2212 x 1659 pixels. 60° field of view. Color fundus photograph from a handheld portable camera: 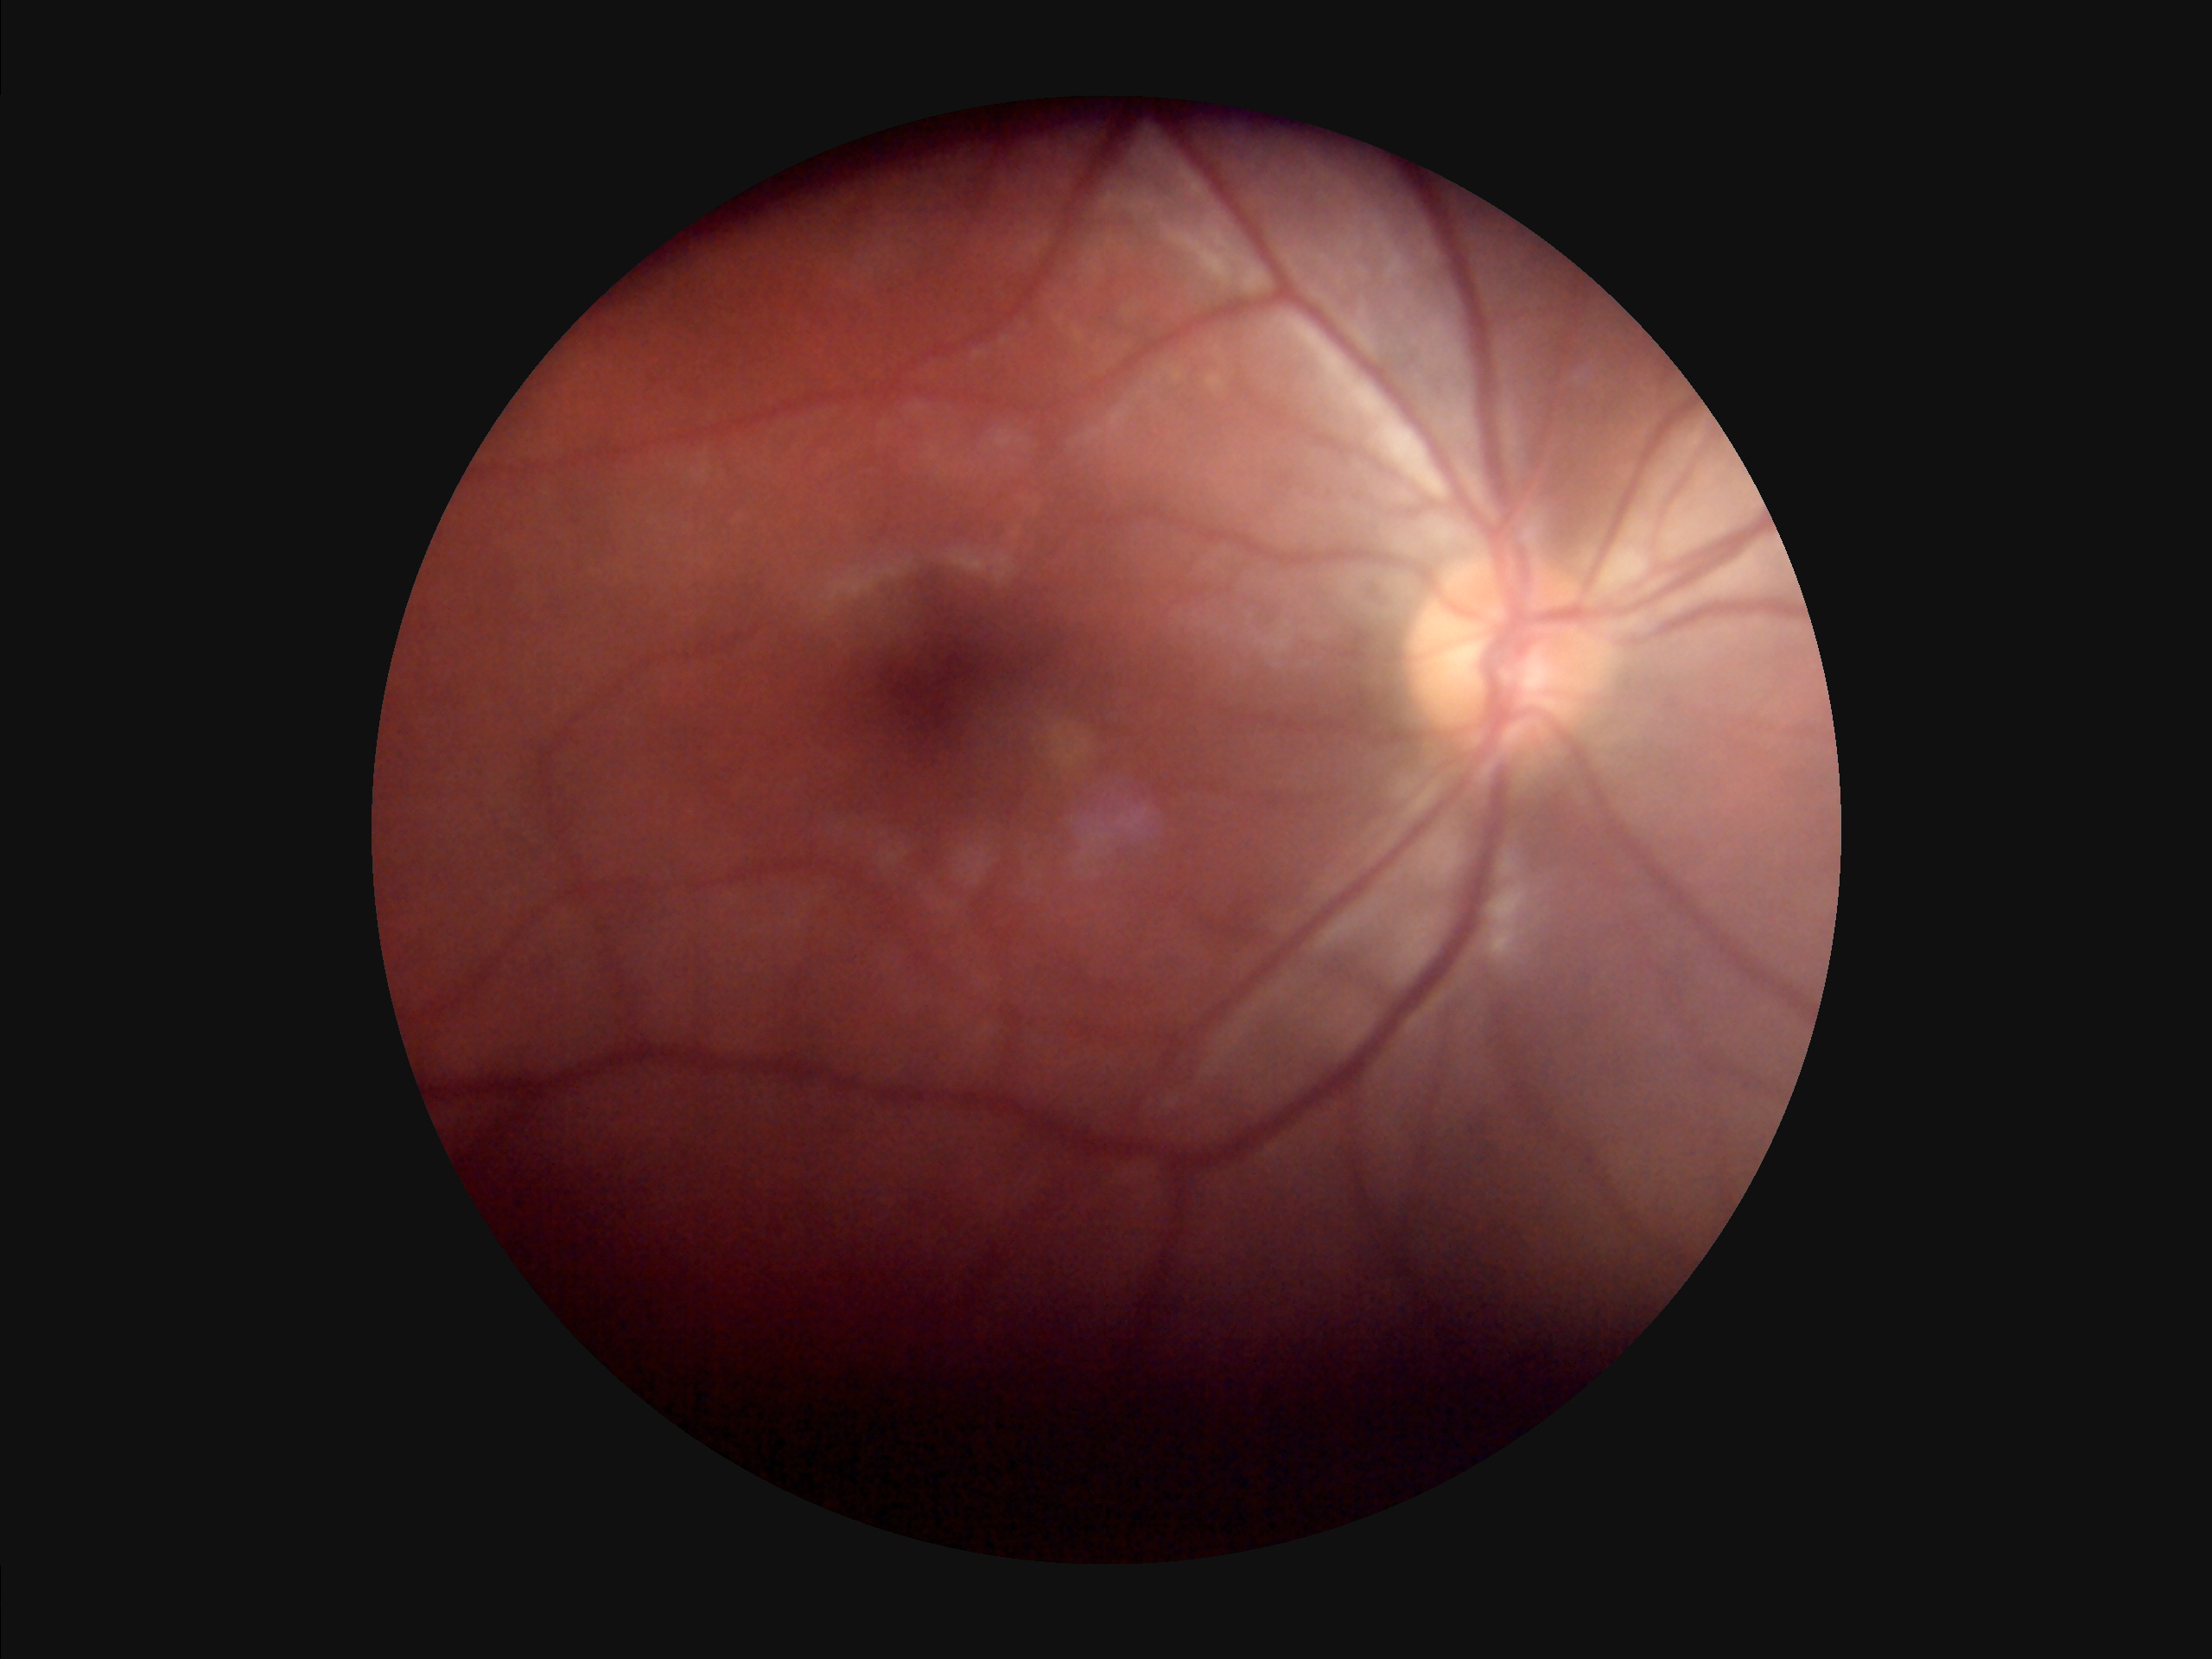 Overall quality is poor; the image is difficult to grade.
Image is sharp throughout the field.
Illumination and color are suboptimal.